848x848 · without pupil dilation · modified Davis classification · CFP: 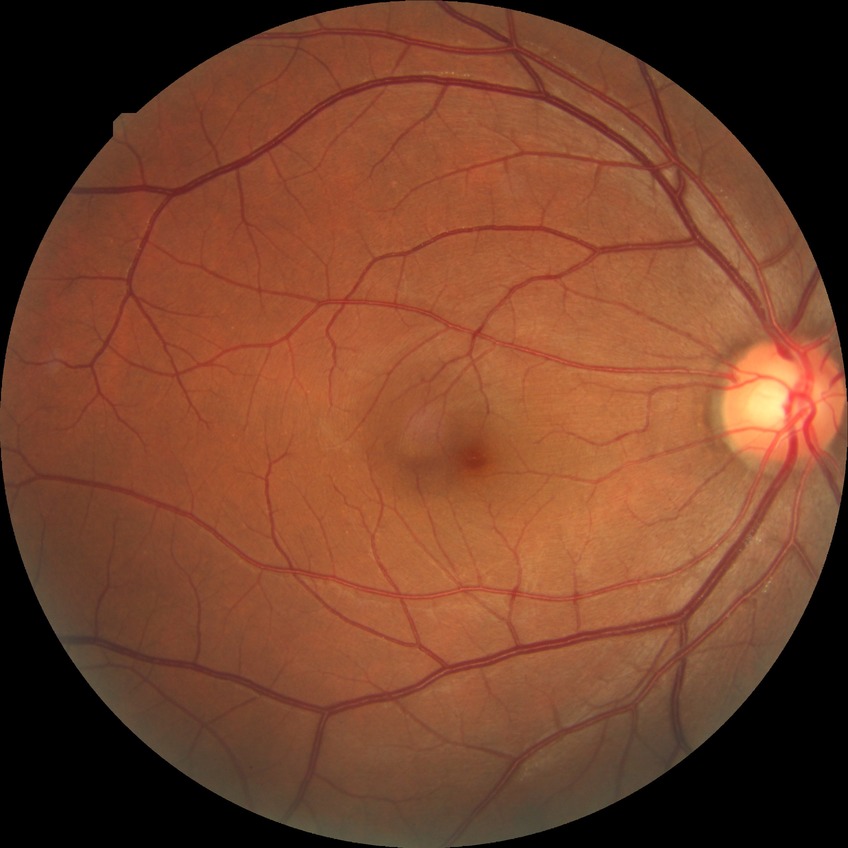 Diabetic retinopathy (DR) is NDR (no diabetic retinopathy).